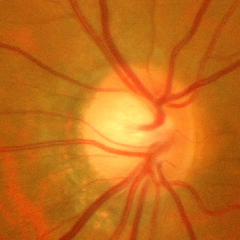 Findings consistent with glaucoma. Demonstrates advanced-stage glaucoma.